Tabletop color fundus camera image: 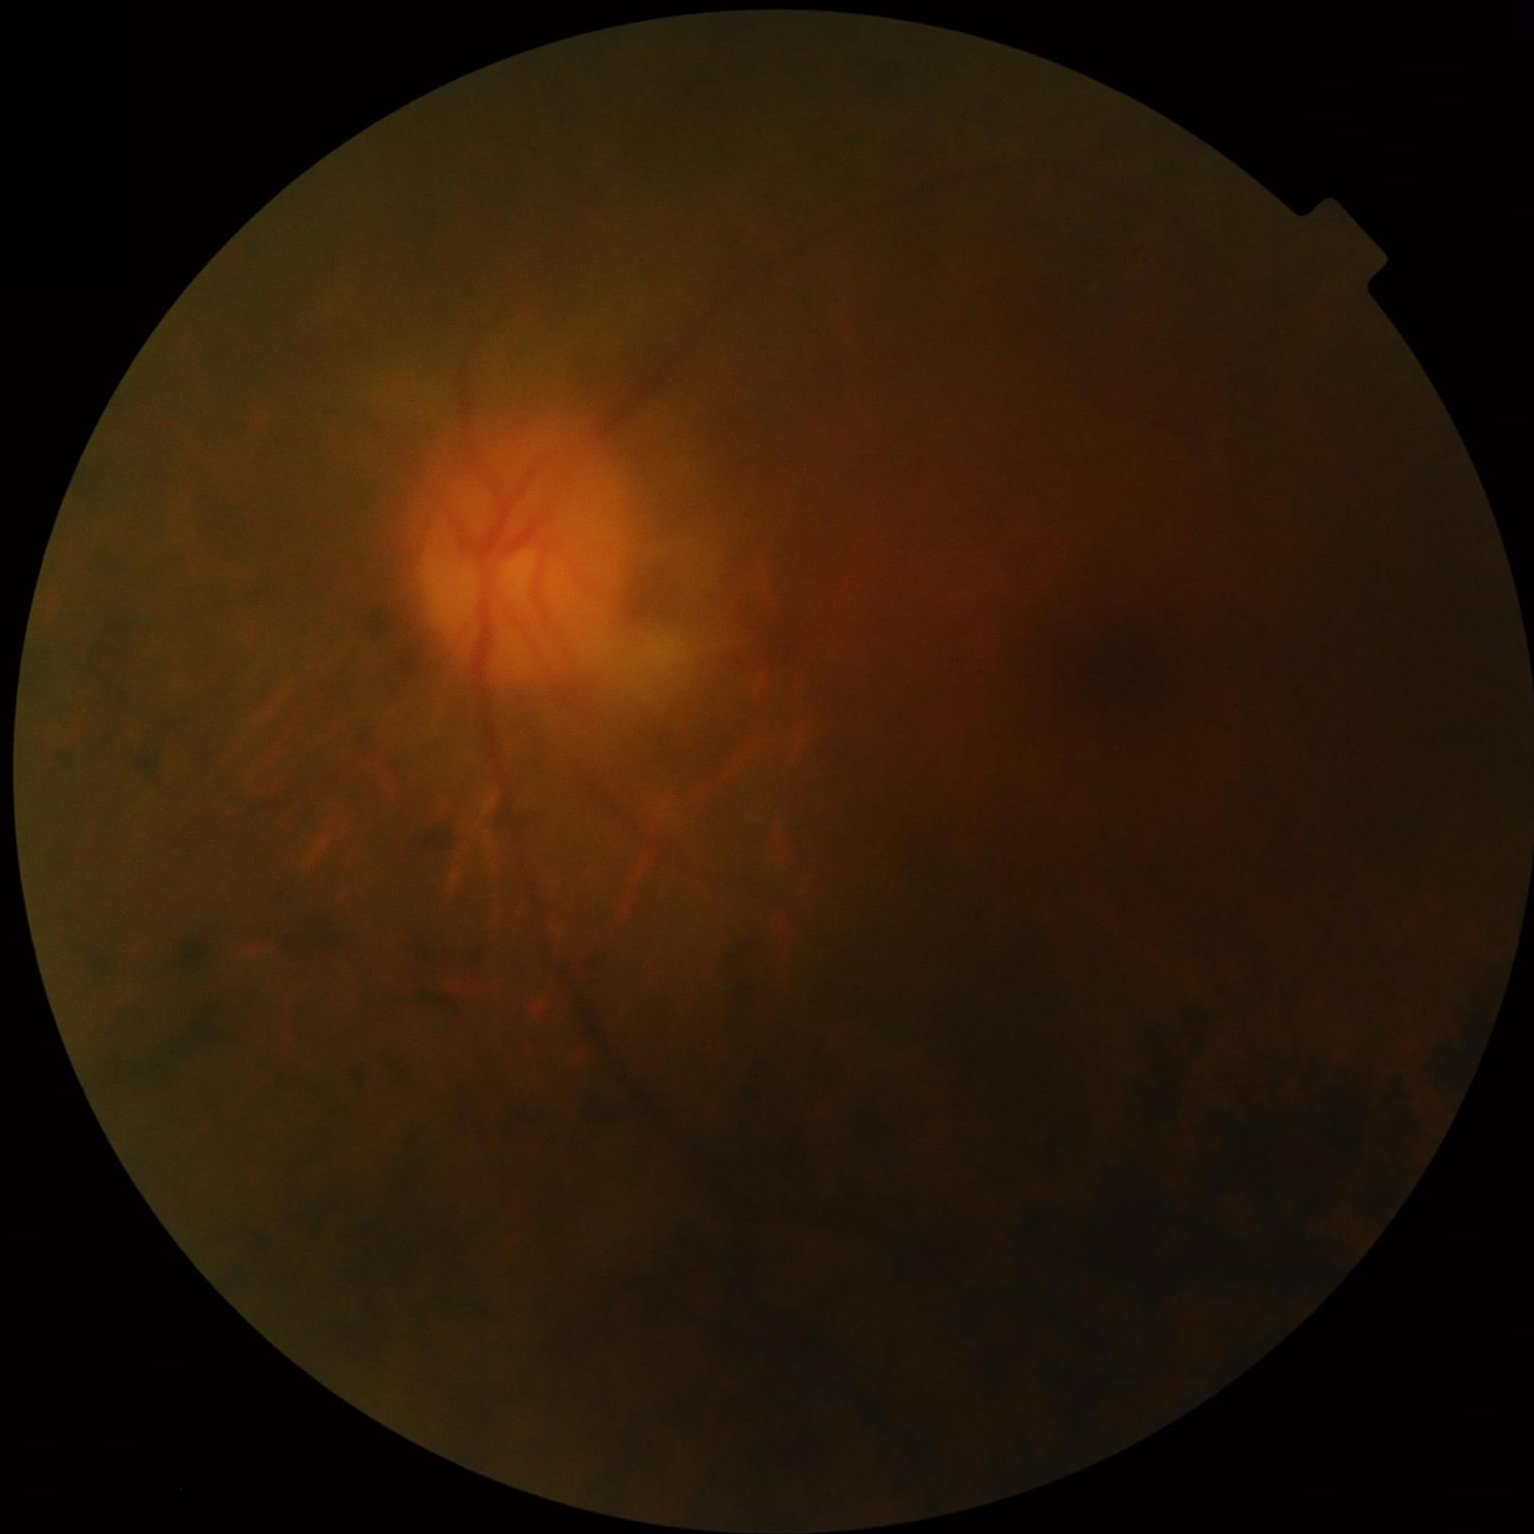
Out of focus; structures are indistinct.
Poor dynamic range.
Overall image quality is poor.
Illumination is uneven.